Nonmydriatic. 45° FOV. Posterior pole photograph. Acquired with a NIDEK AFC-230: 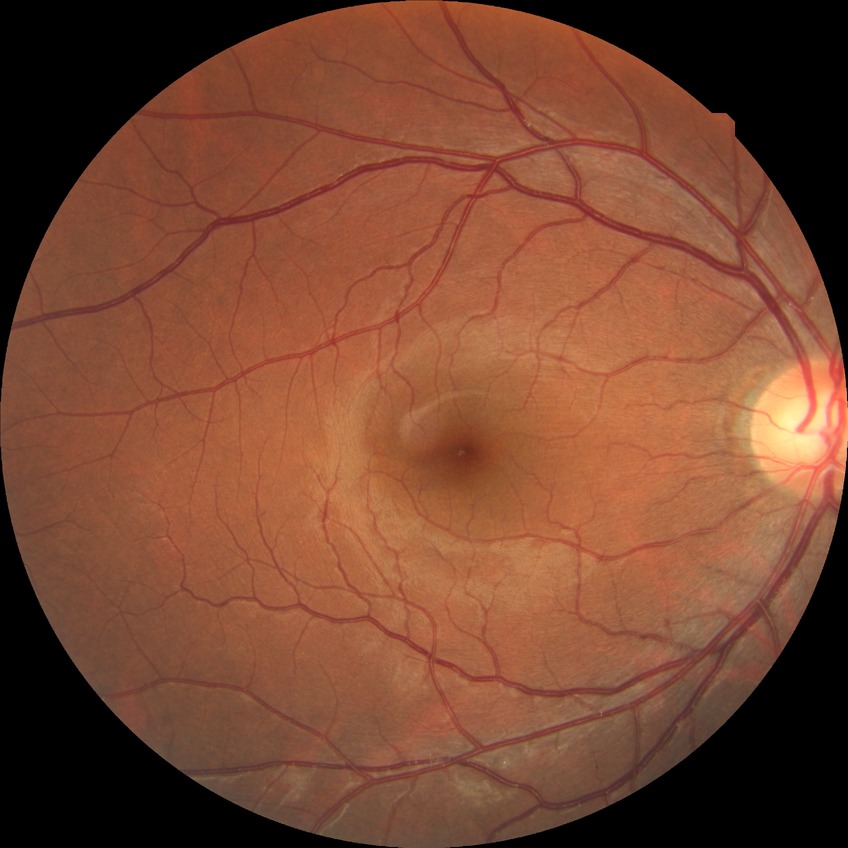 Diabetic retinopathy (DR) is NDR (no diabetic retinopathy).